Image size 2352x1568:
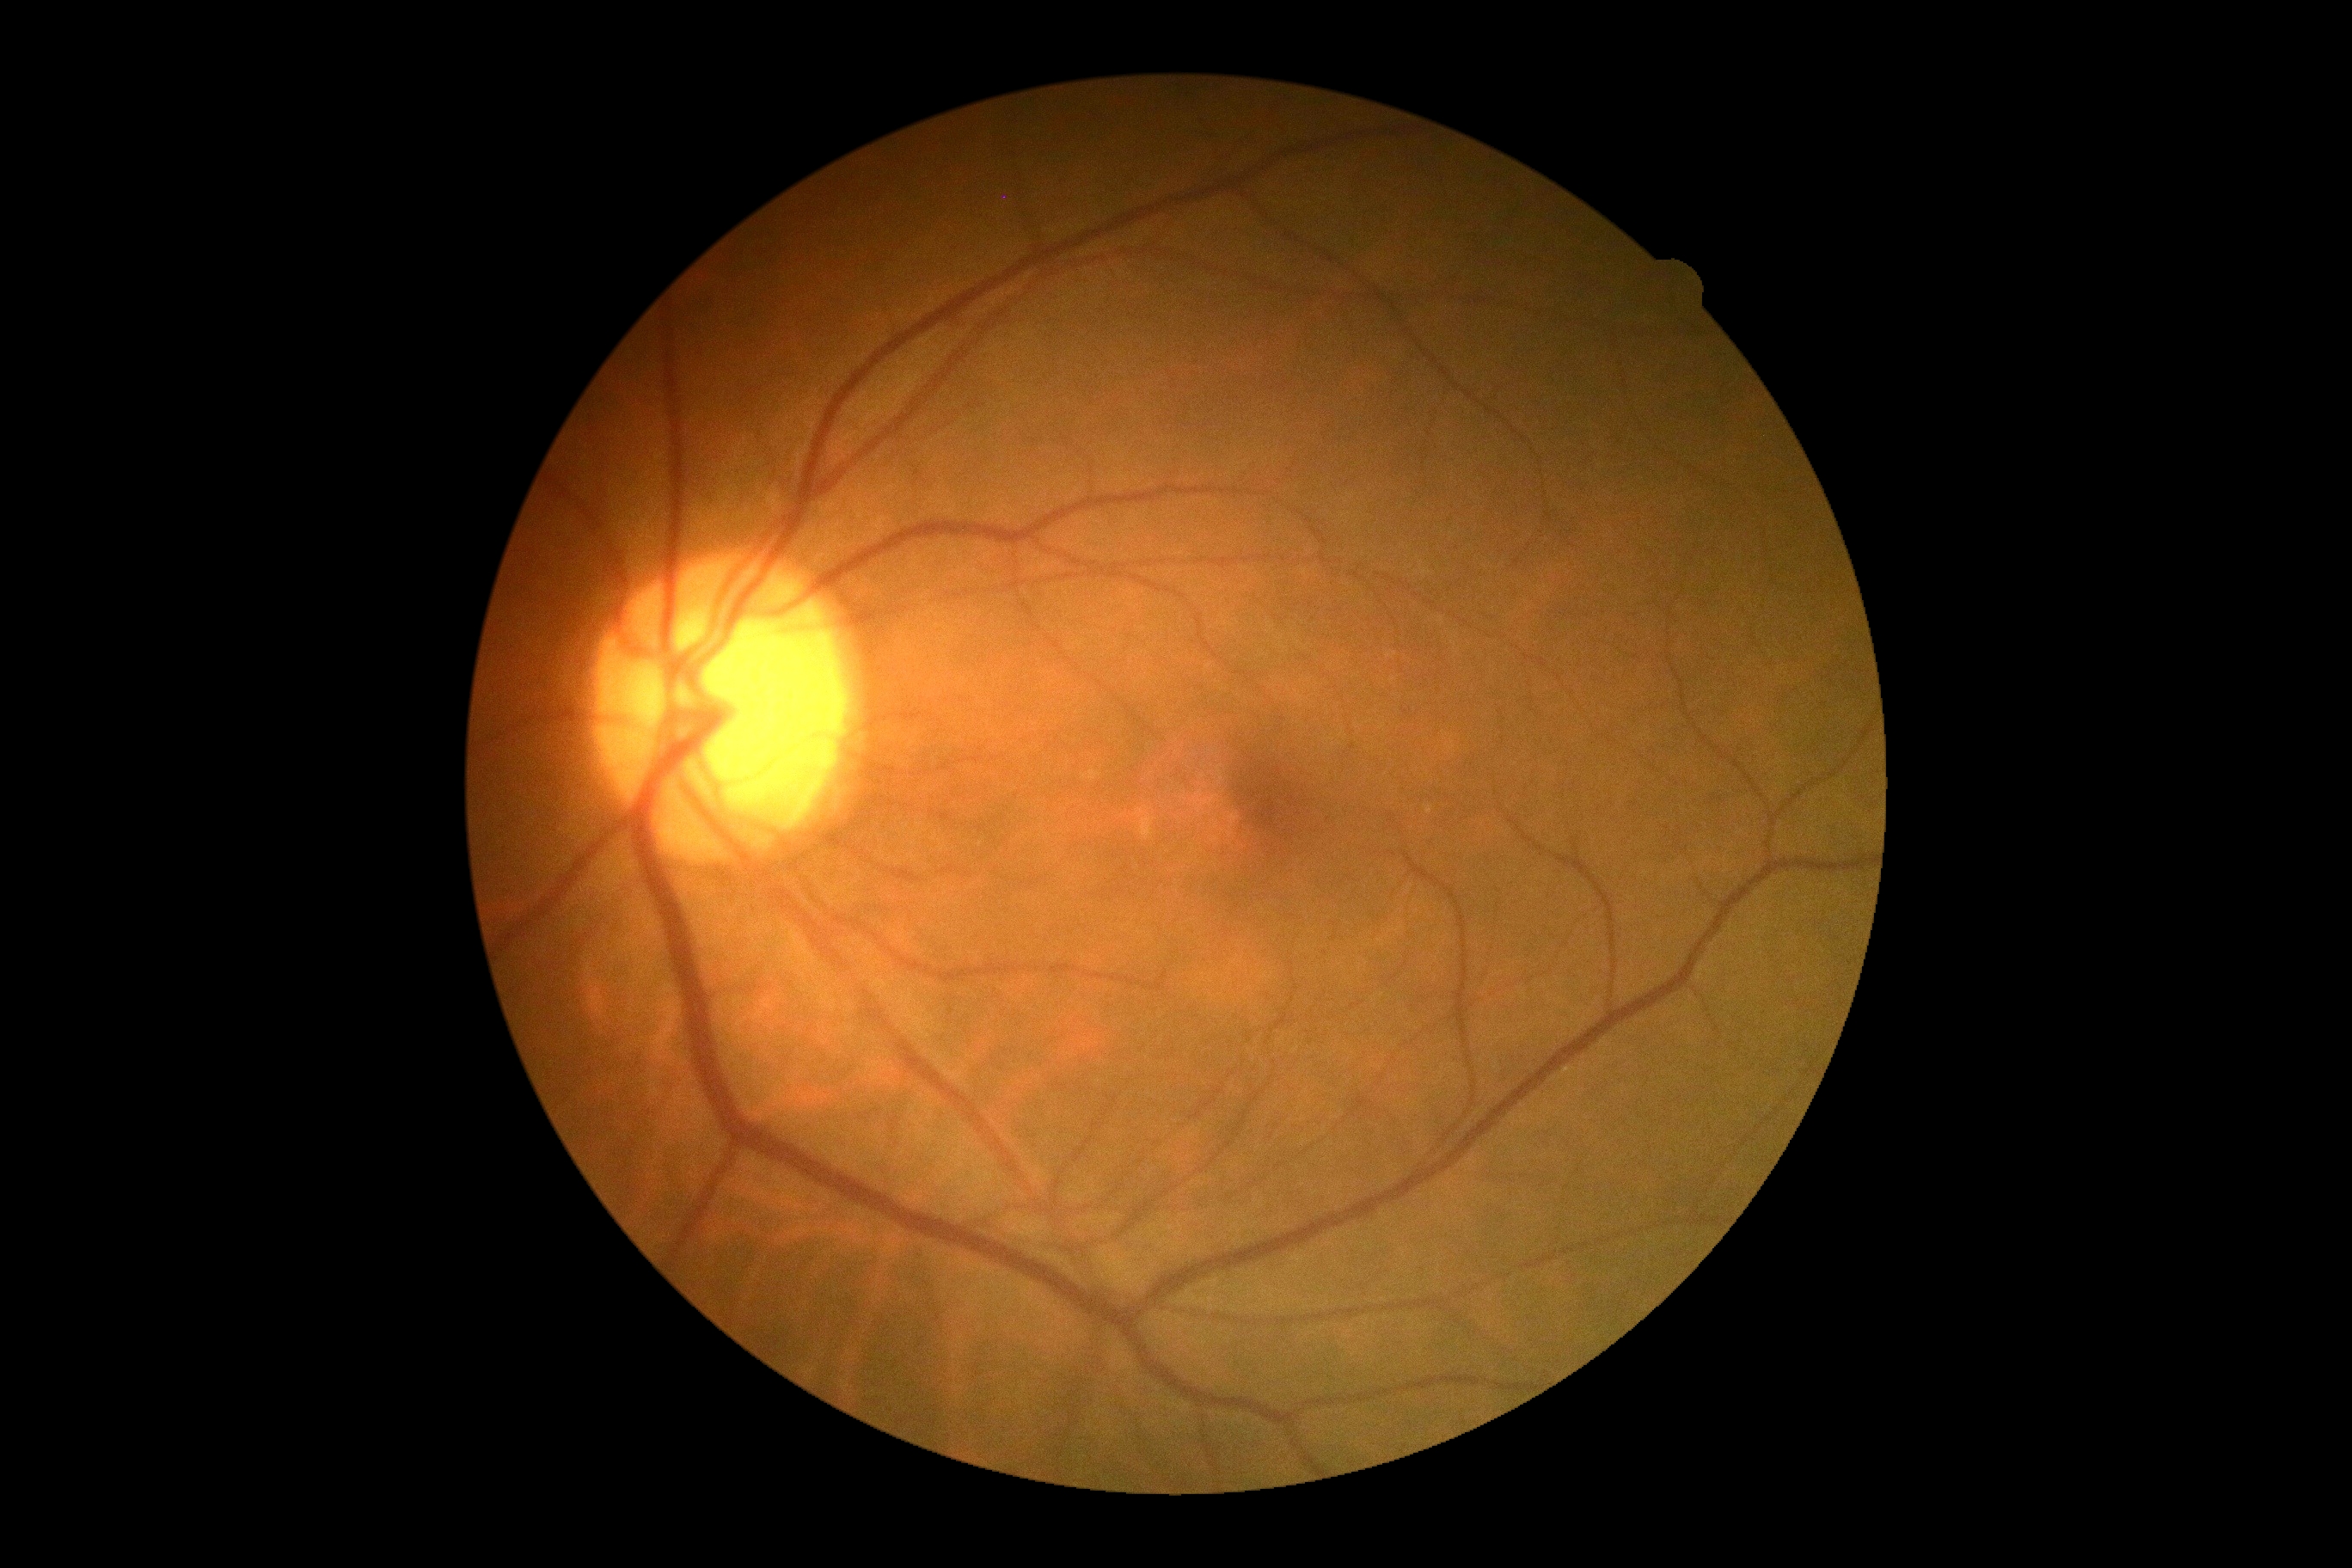
Retinopathy: no apparent retinopathy (grade 0).